45° FOV.
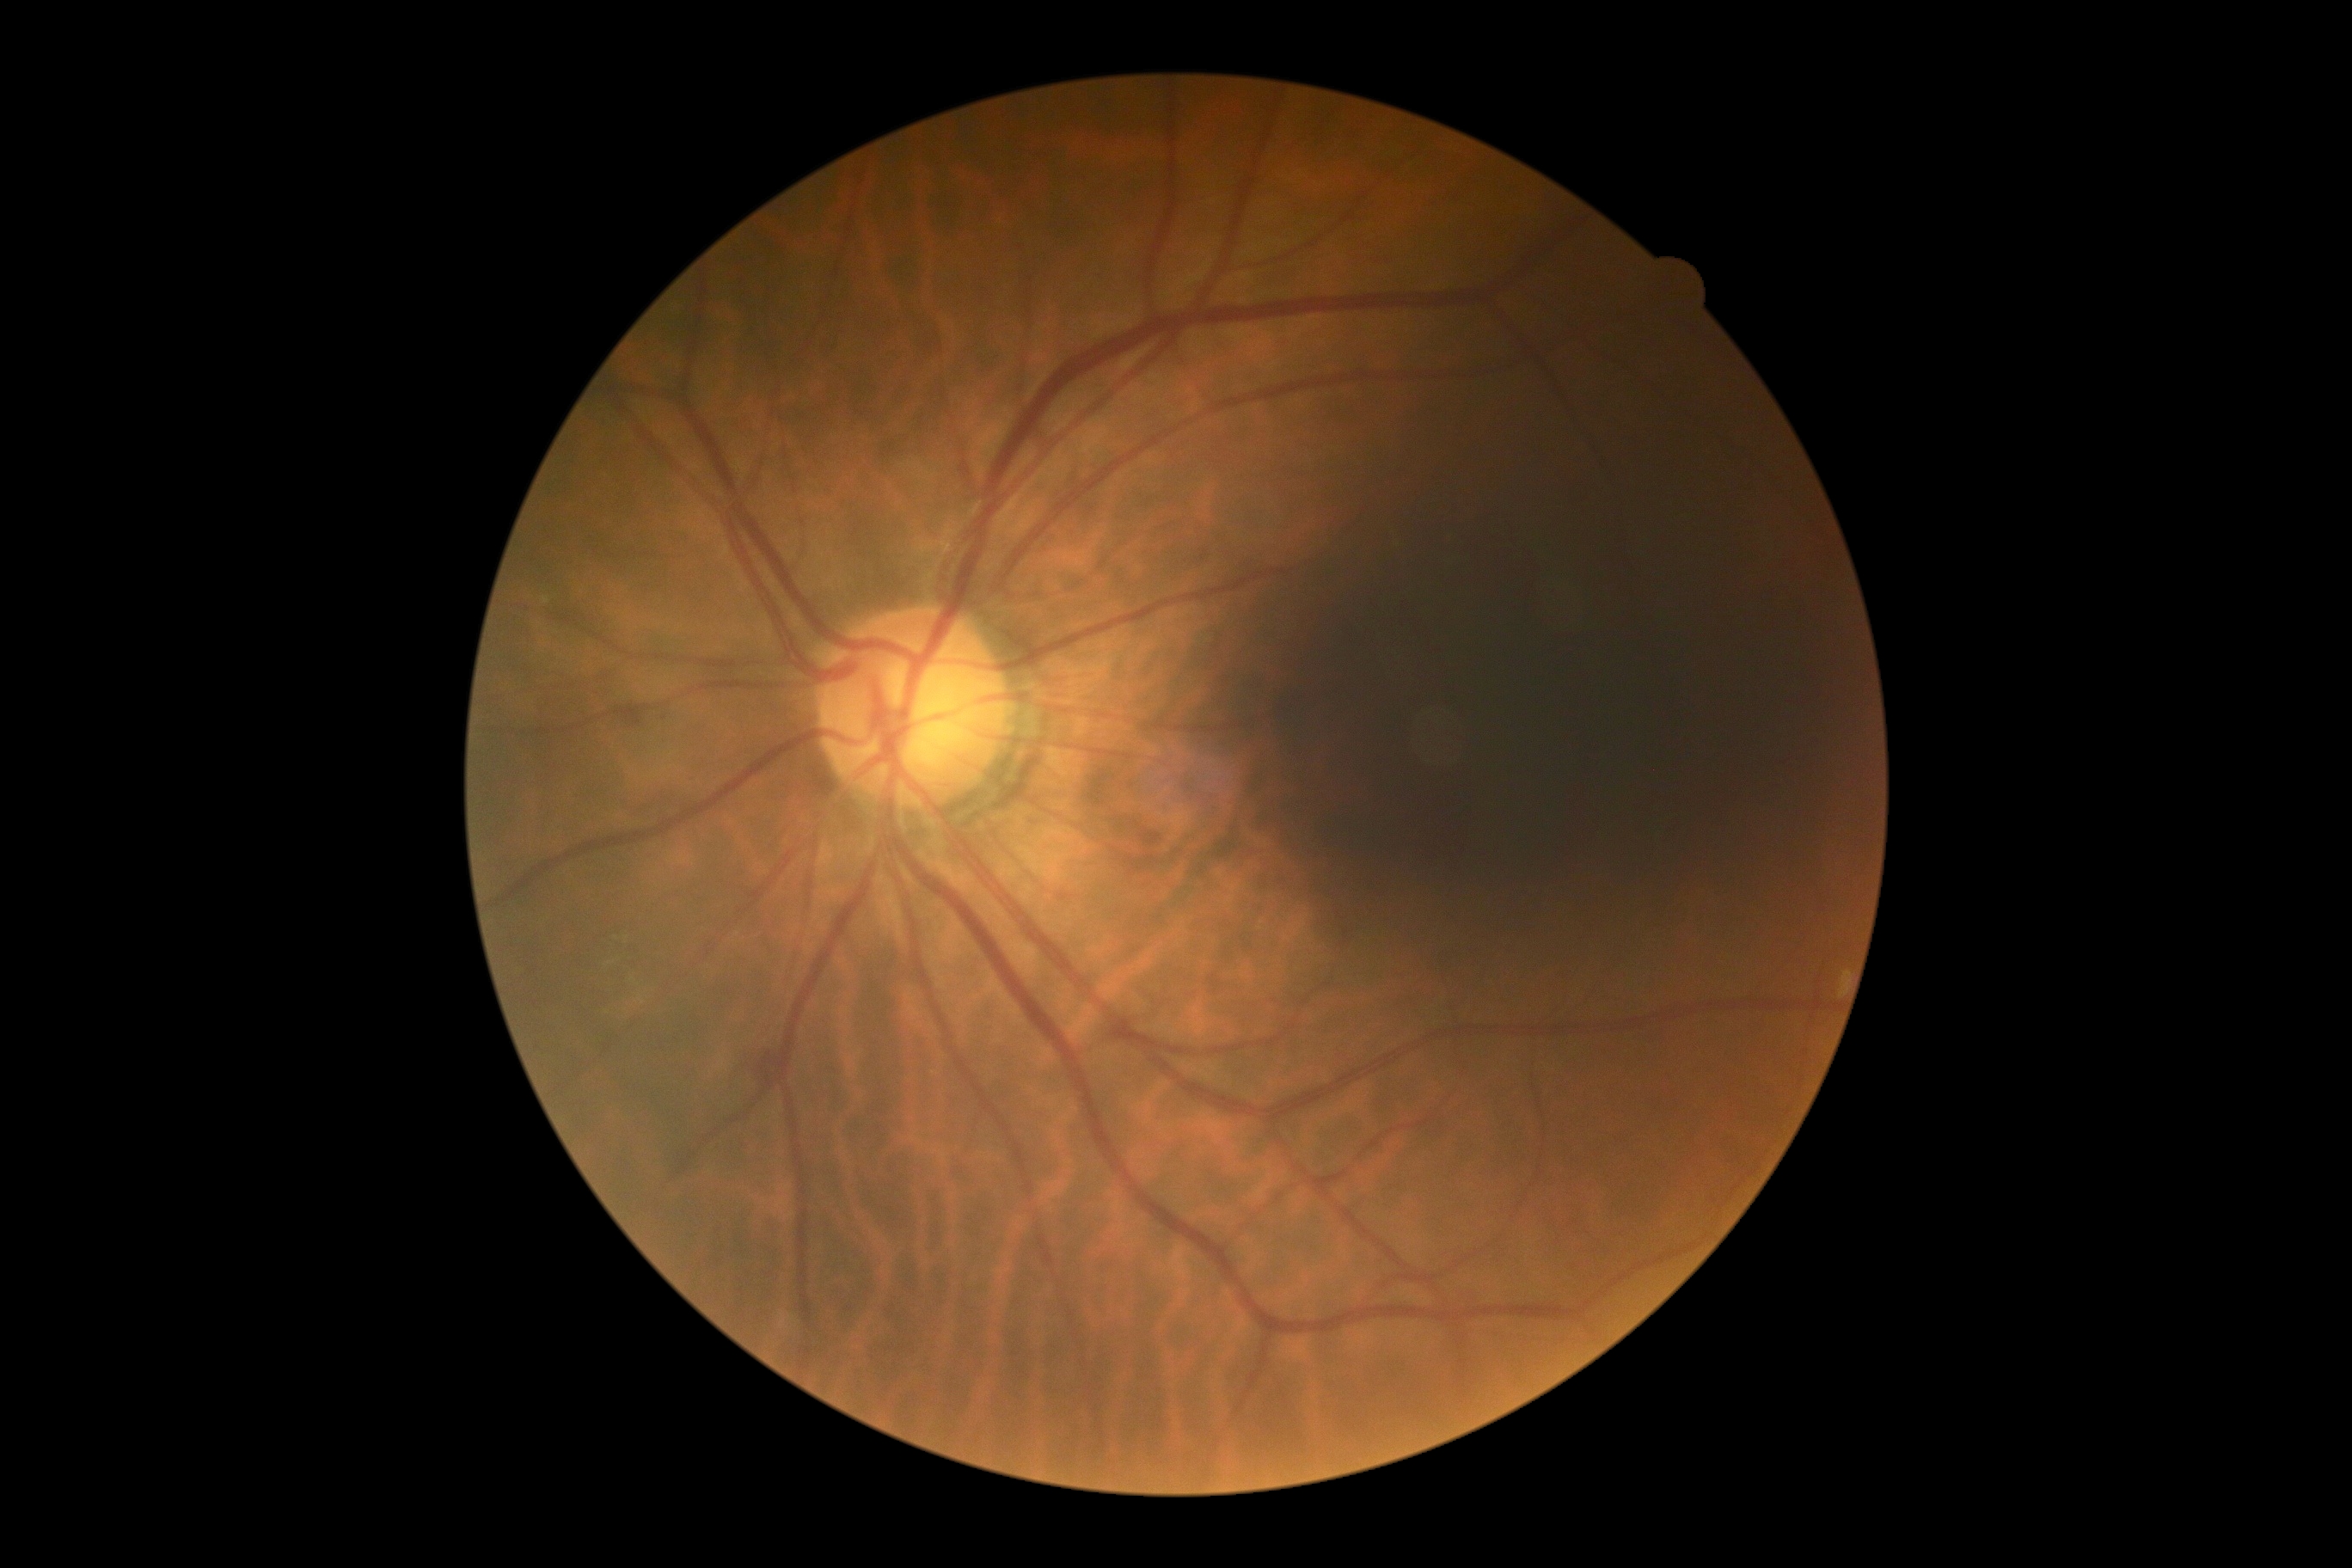
DR severity=2.